Optic nerve head photograph · cropped from a 35-degree field of view — 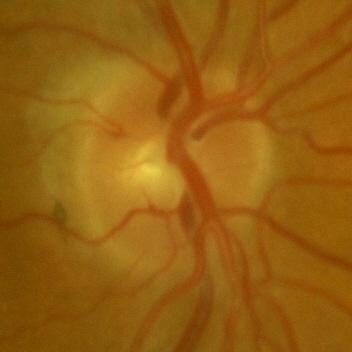

Optic disc appearance consistent with no glaucomatous findings.